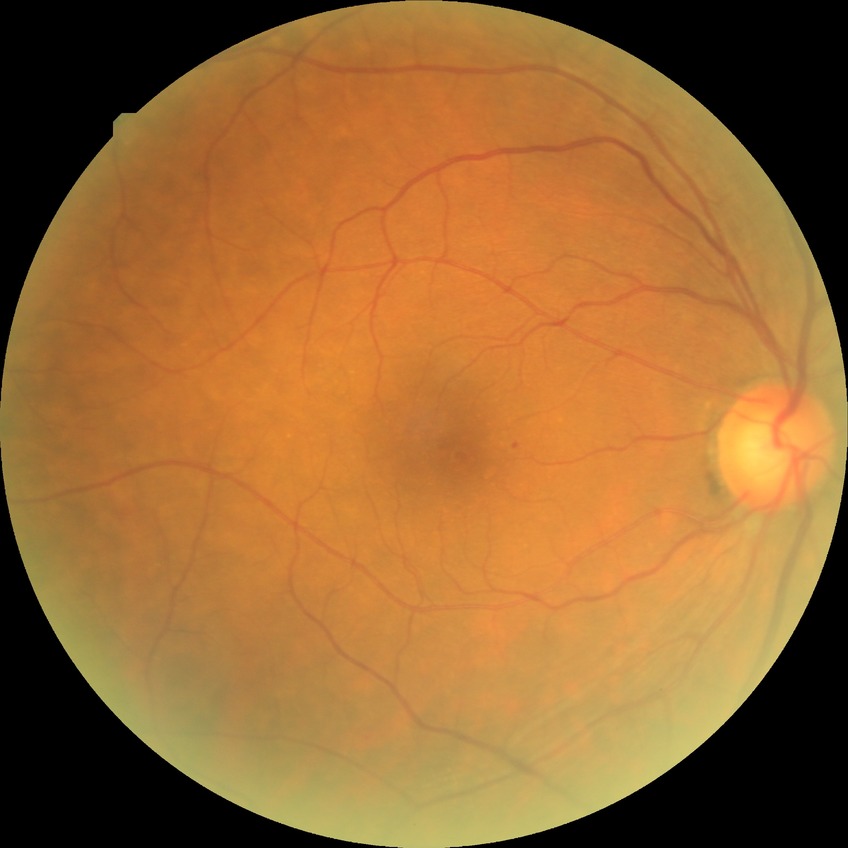 Retinopathy grade: no diabetic retinopathy.